Captured after pupil dilation.
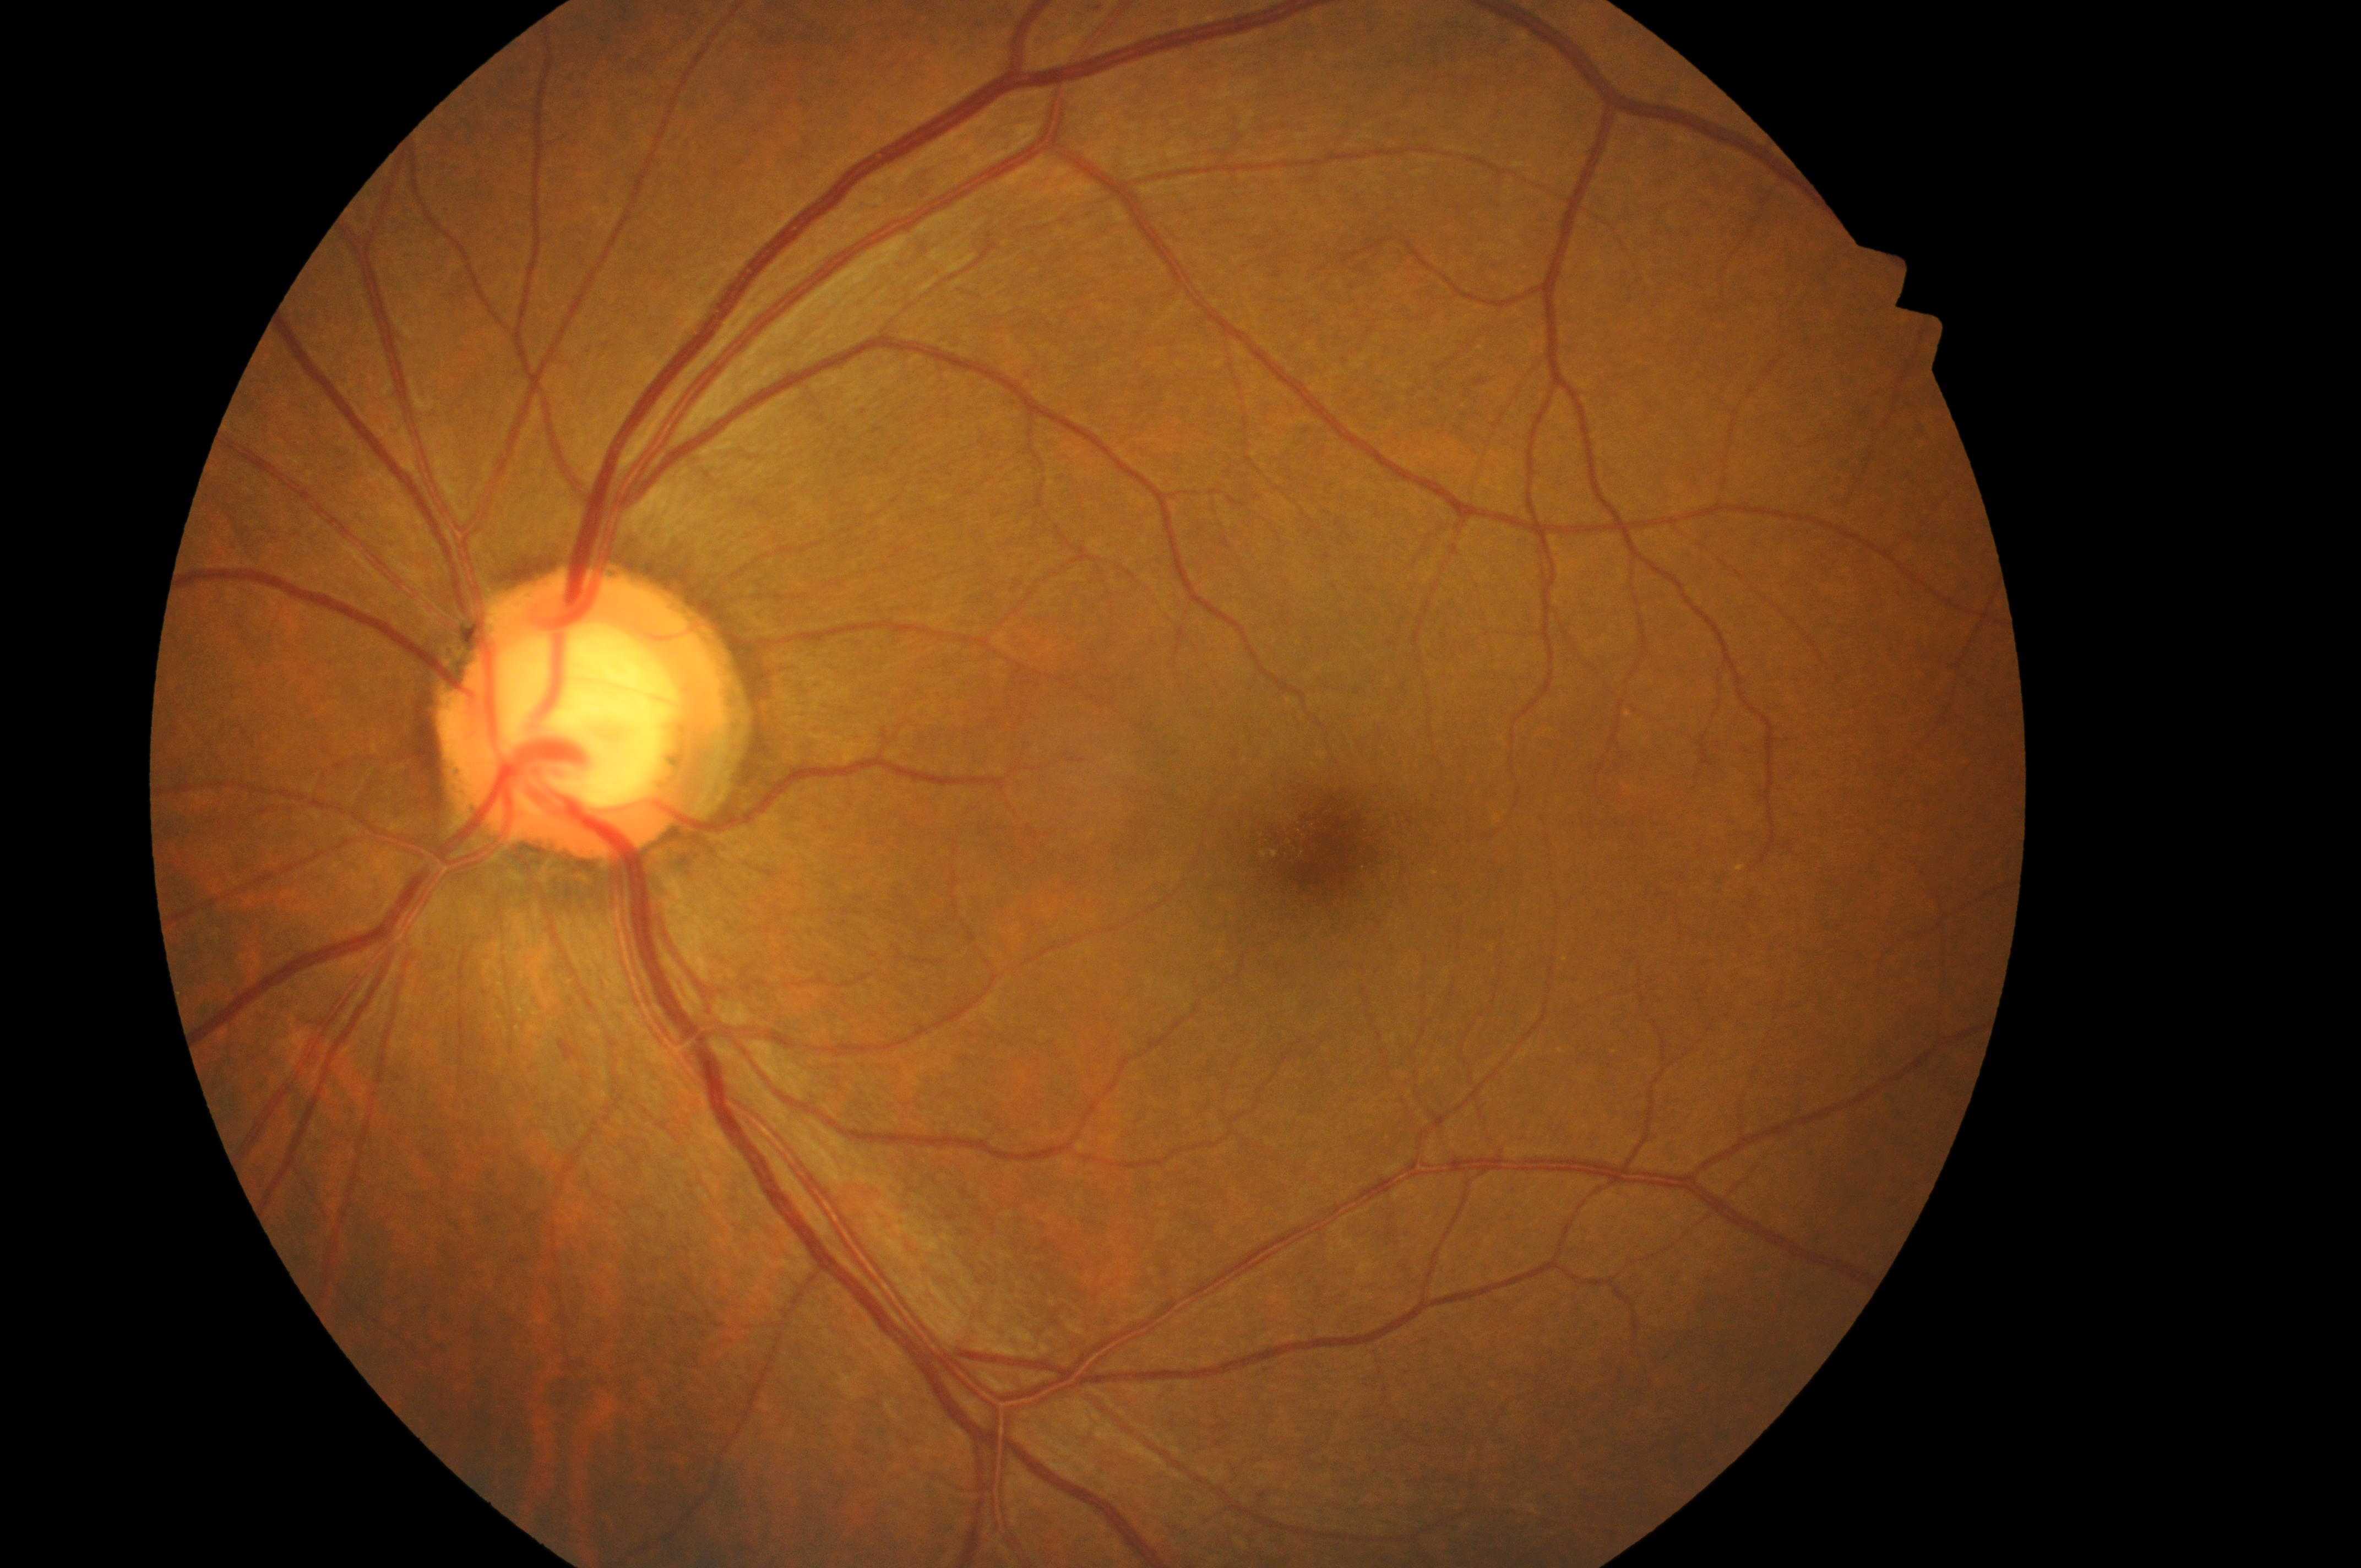 No apparent diabetic retinopathy or macular edema. Diabetic macular edema (DME): no risk (grade 0). Fovea center located at x=1332, y=847. The image shows the OS. Optic disc: x=584, y=723. Diabetic retinopathy (DR) is grade 0 (no apparent retinopathy).